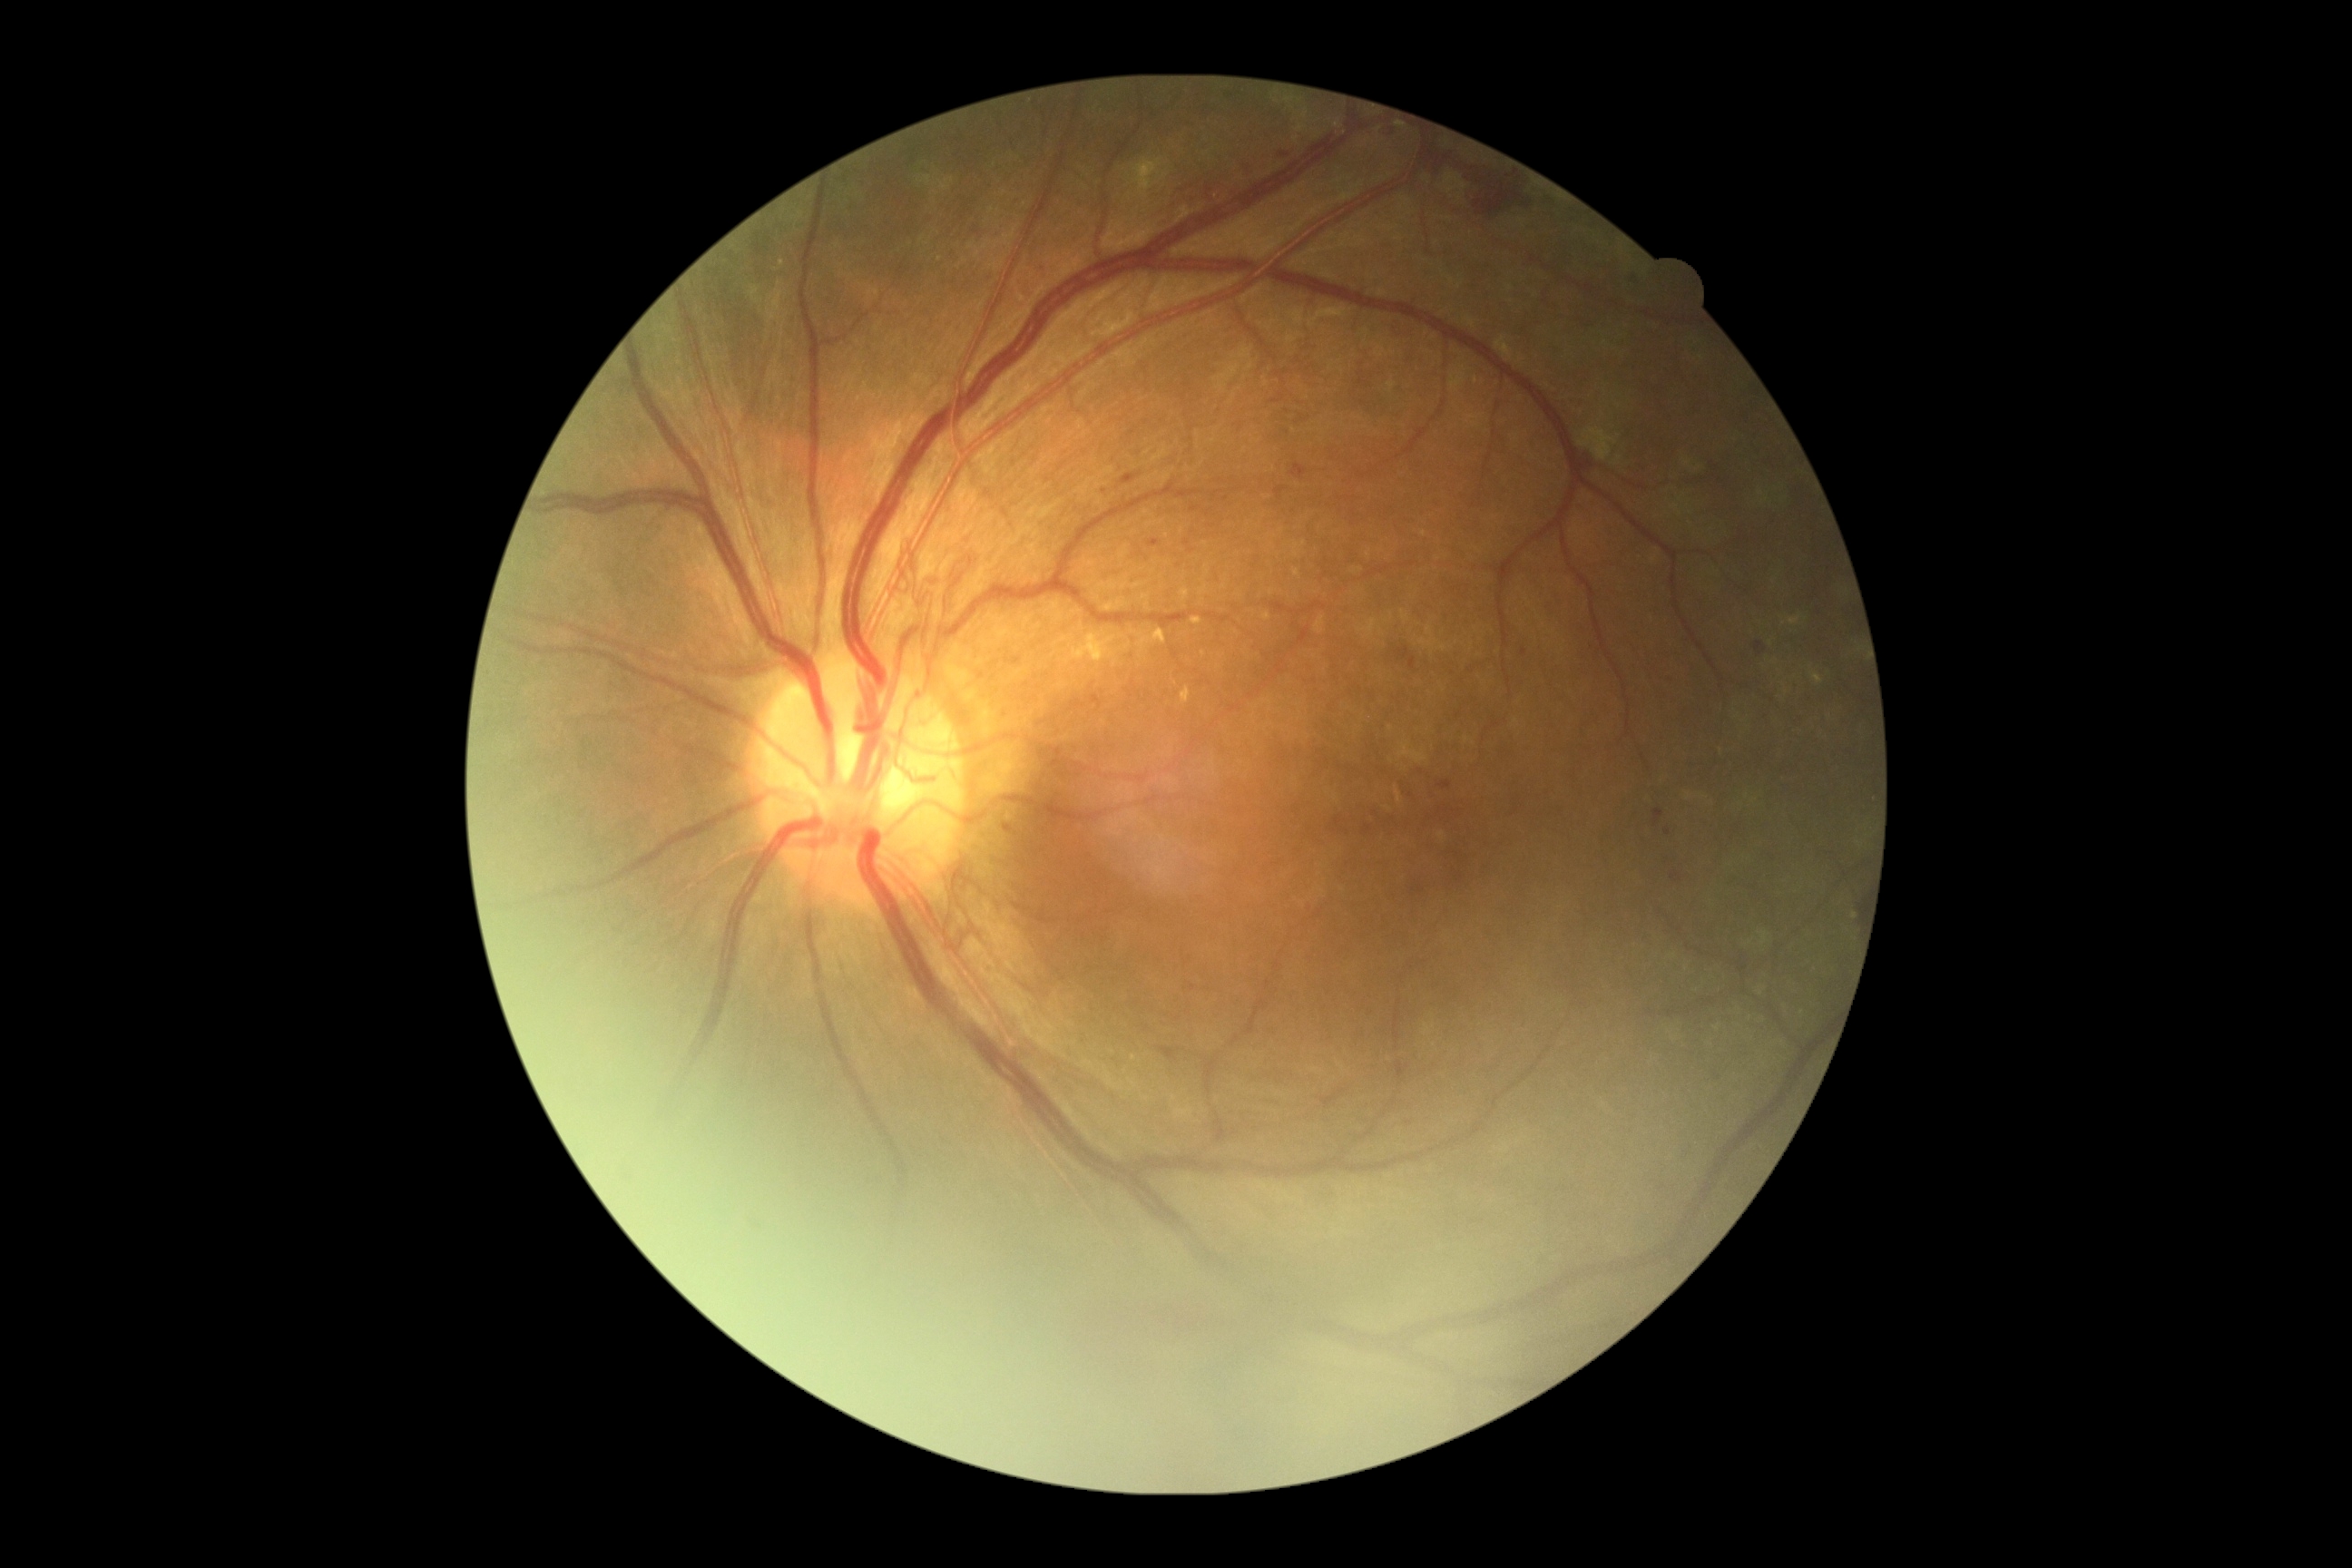 Diabetic retinopathy severity is grade 4 (PDR).